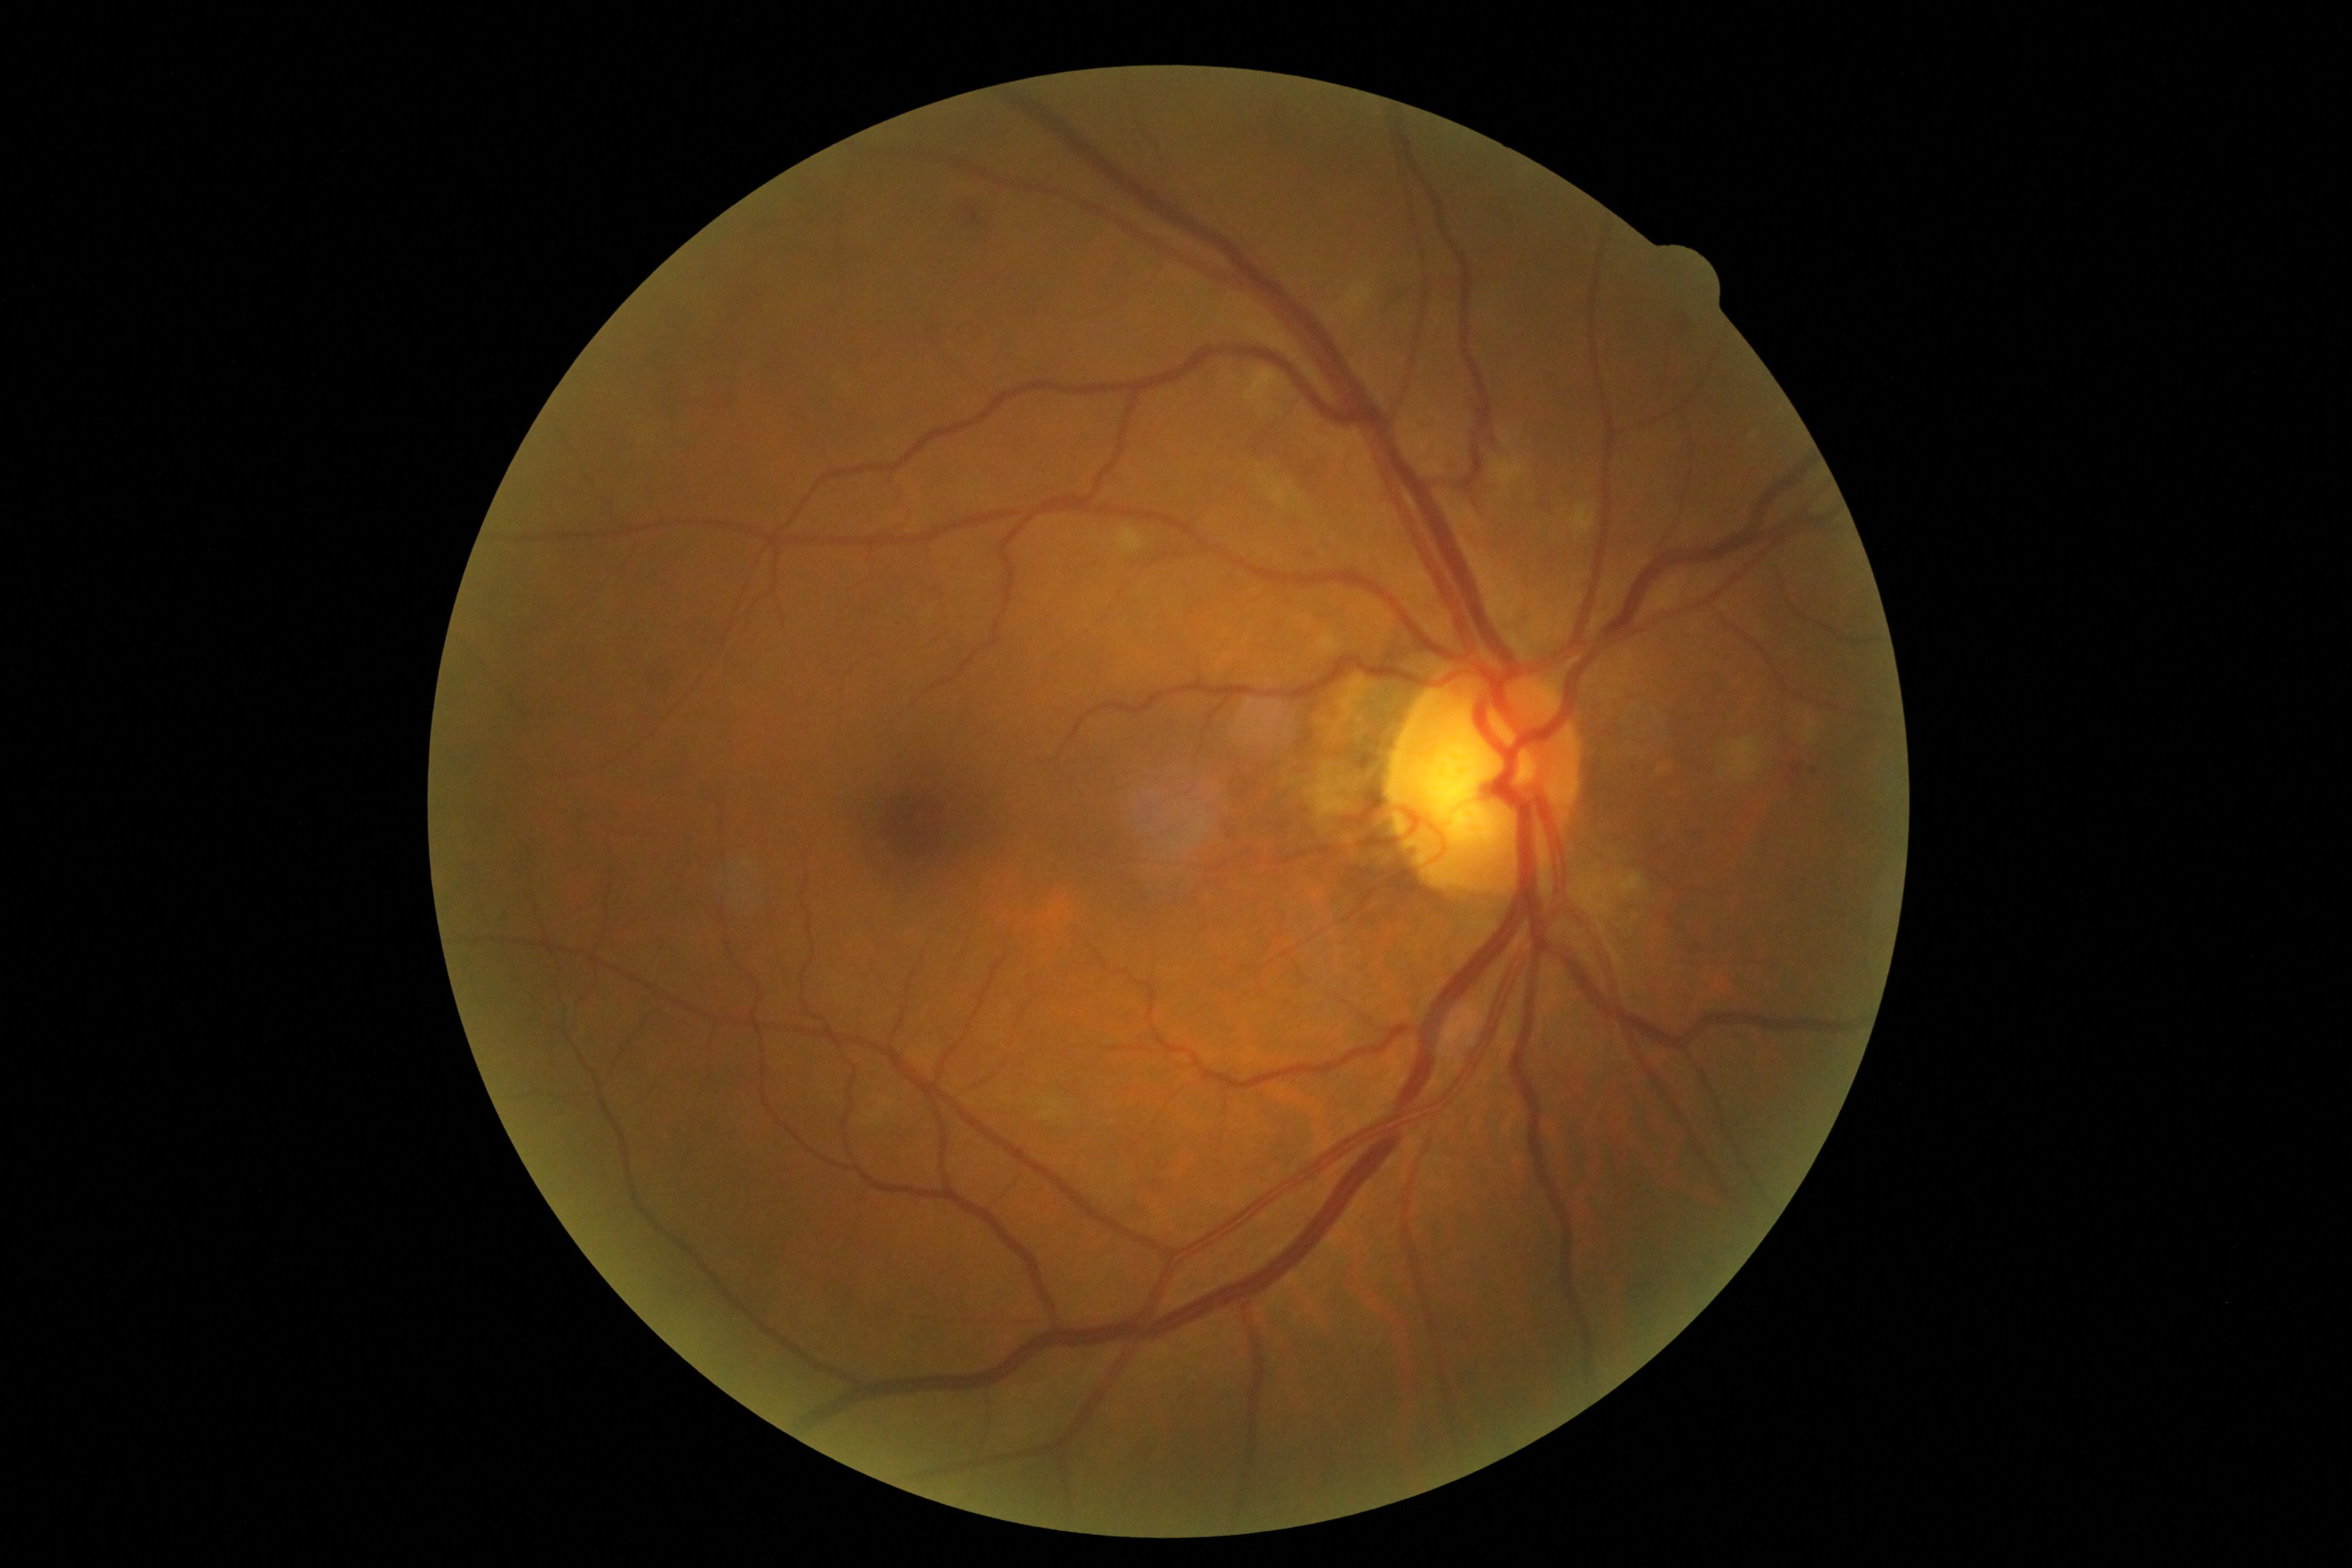
Diabetic retinopathy (DR): grade 2 (moderate NPDR)
Selected lesions:
* hemorrhages (HEs): bbox(646, 659, 670, 695) | bbox(953, 199, 1002, 236) | bbox(1678, 314, 1703, 338) | bbox(1388, 276, 1415, 308)
* microaneurysms (MAs): bbox(1793, 764, 1800, 774)
* Small MAs approximately at (1003; 853) | (1815; 771) | (1788; 779)
* hard exudates (EXs): not present
* soft exudates (SEs) (partial): bbox(869, 1109, 885, 1125) | bbox(1243, 367, 1287, 405) | bbox(1288, 488, 1296, 495) | bbox(1492, 458, 1526, 491) | bbox(1806, 719, 1818, 741) | bbox(1343, 287, 1371, 312) | bbox(1618, 873, 1642, 896) | bbox(1731, 738, 1761, 782) | bbox(1272, 488, 1287, 506) | bbox(1041, 1096, 1062, 1118) | bbox(1118, 527, 1144, 553) | bbox(880, 1098, 895, 1110) | bbox(1258, 402, 1273, 412) | bbox(1570, 503, 1595, 536)
* Small SEs approximately at (1263; 478) | (1258; 466) | (863; 1123)